2048 by 1536 pixels, fundus photo, 45° field of view:
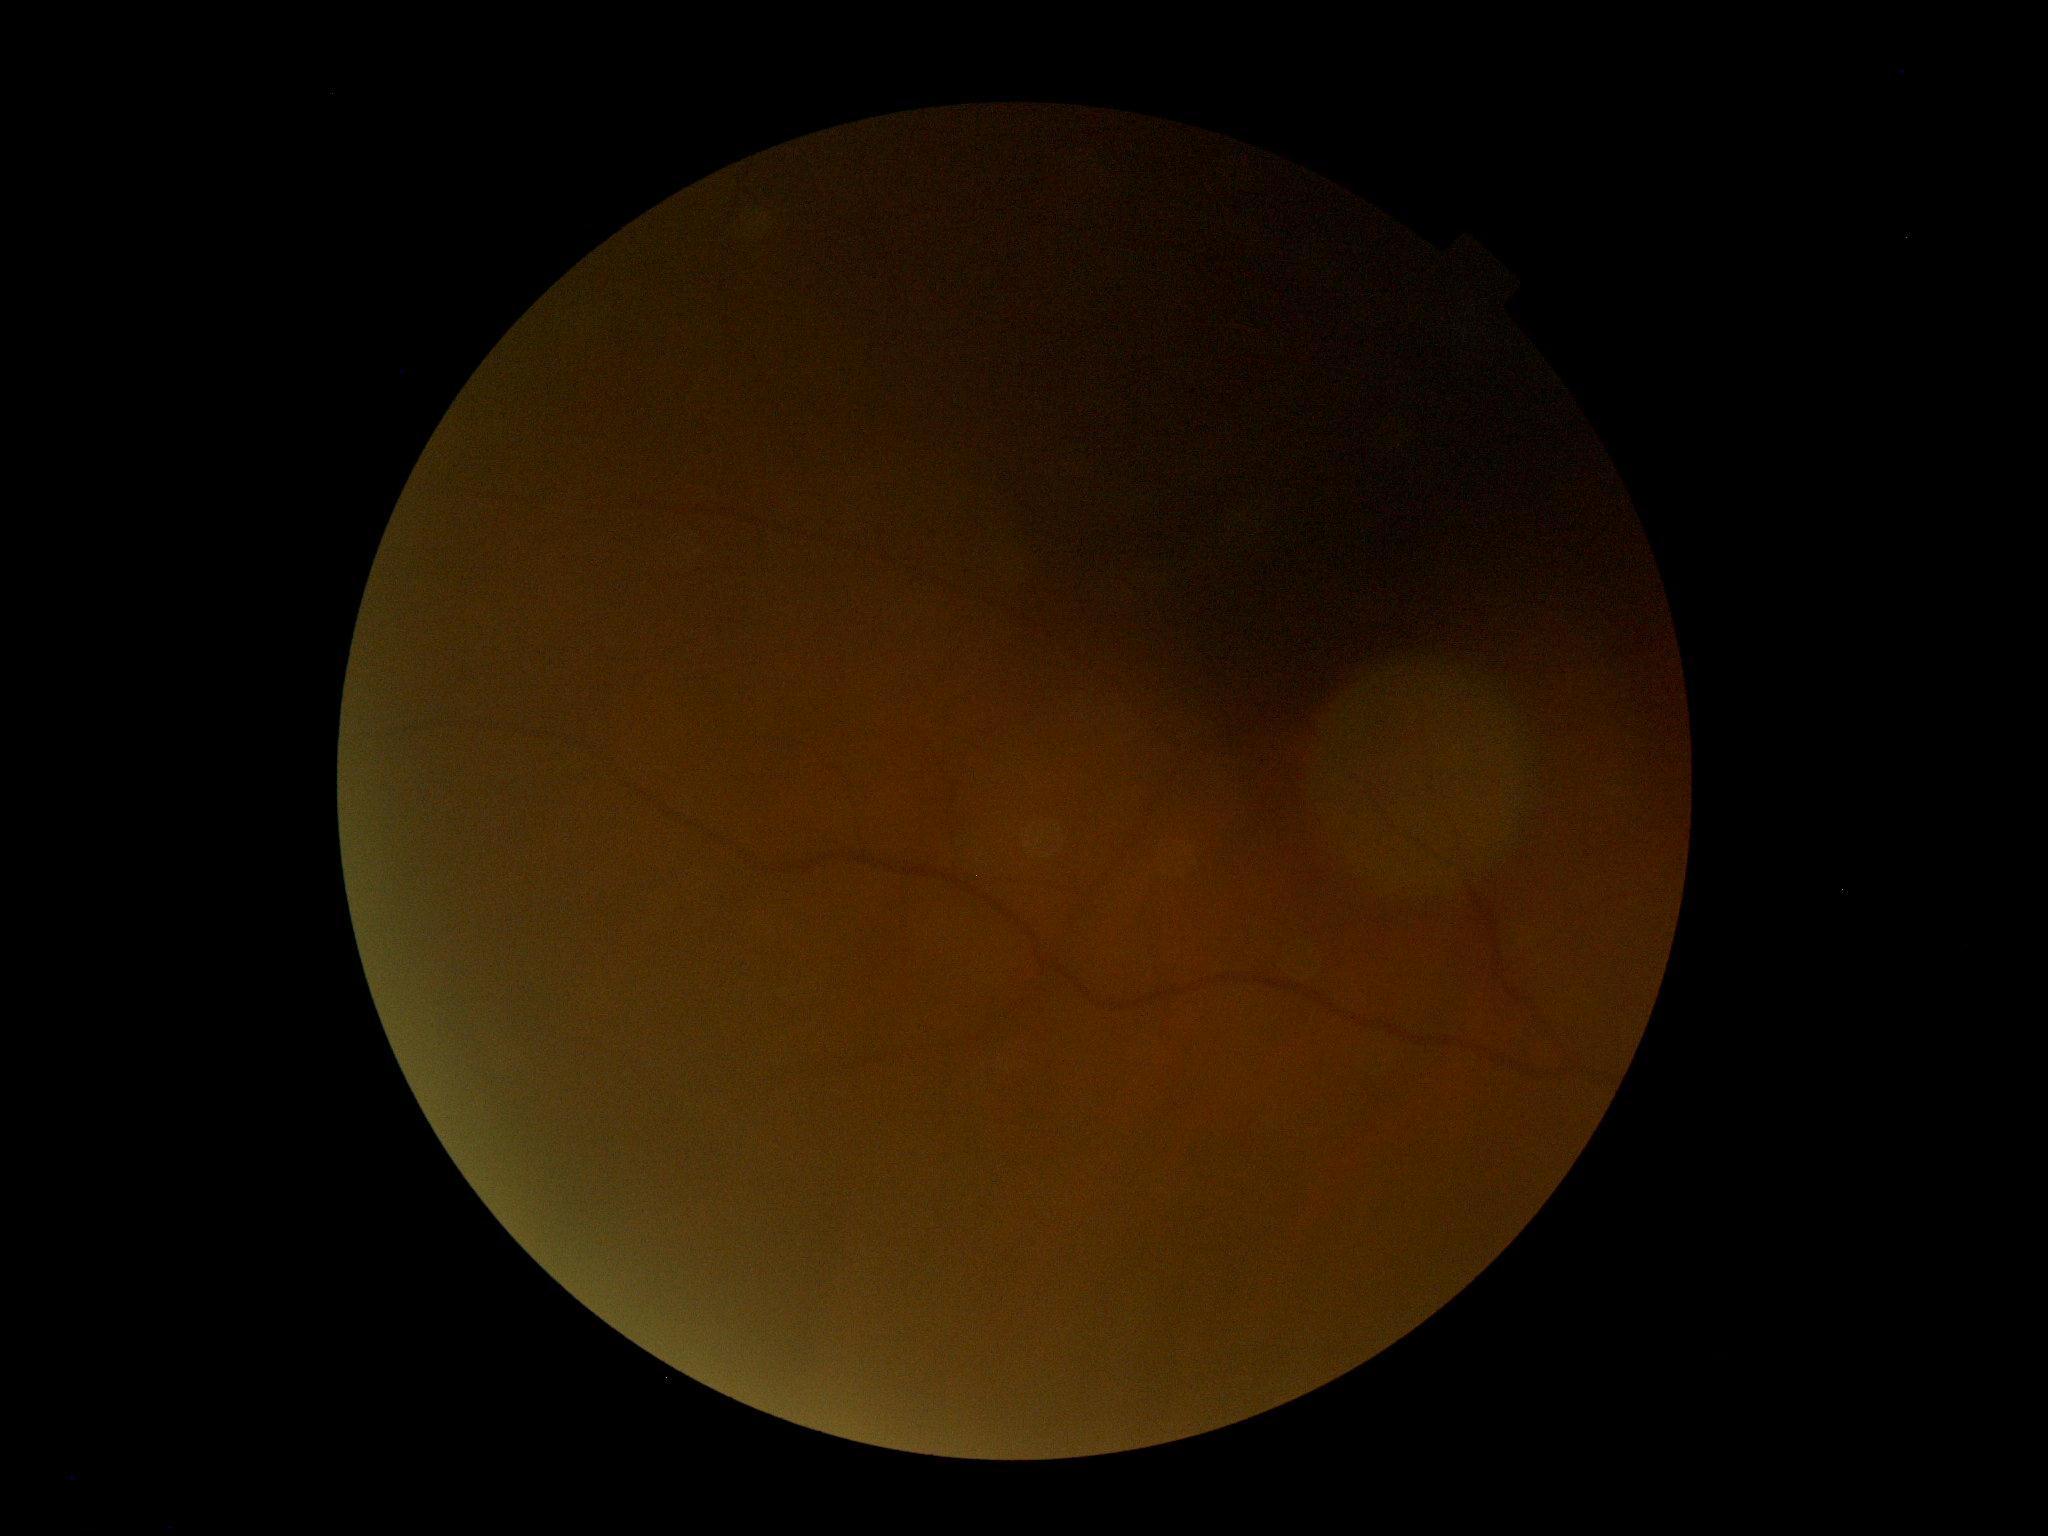 Image quality is insufficient for diabetic retinopathy assessment.
DR stage: ungradable.